Wide-field fundus image from infant ROP screening; 640 x 480 pixels.
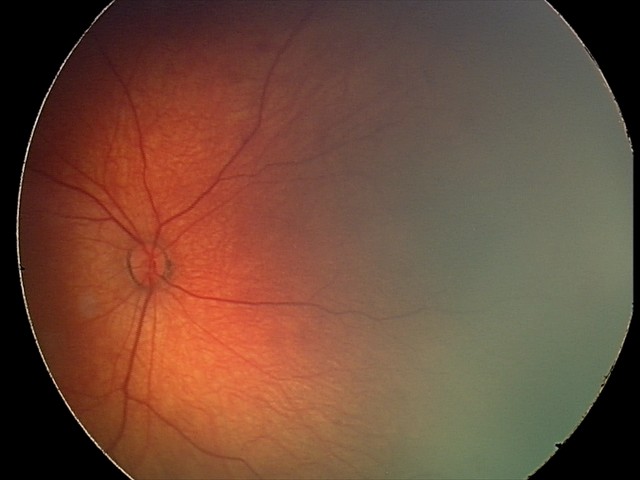
Assessment: retinal hemorrhages